2184x1690px — 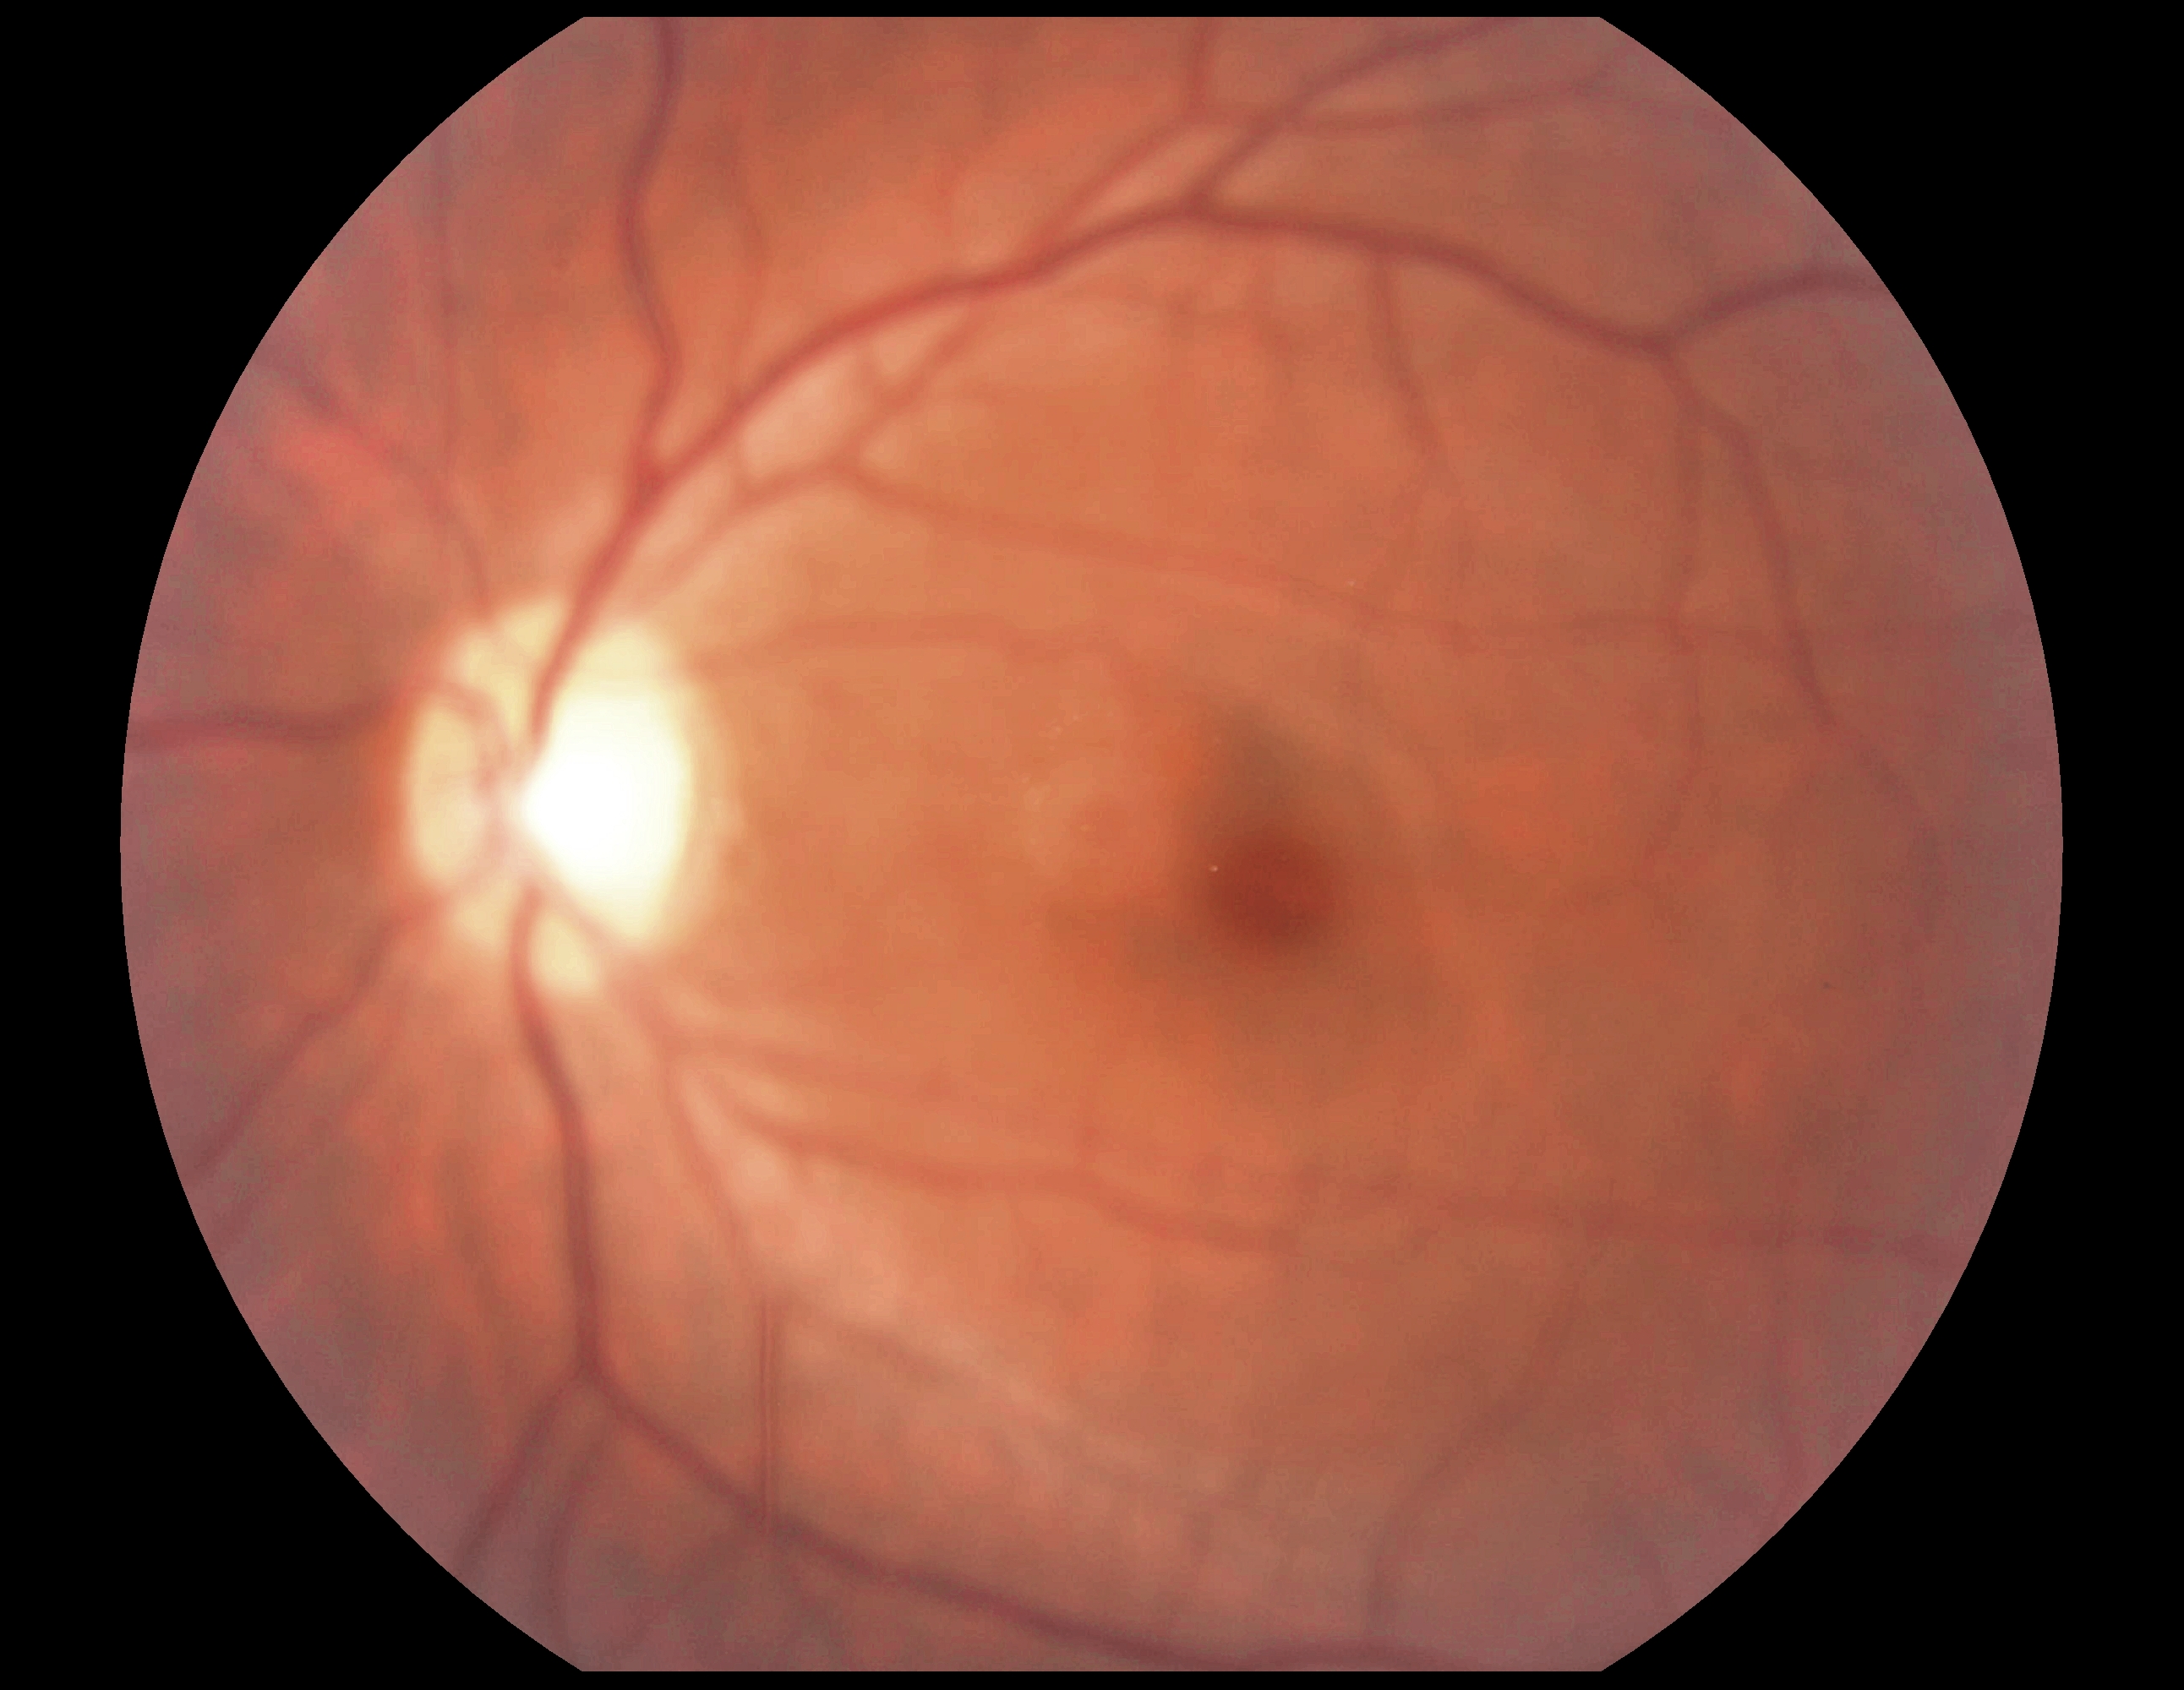 DR grade@0 (no apparent retinopathy); DR impression@no DR findings.